1240 x 1240 pixels; pediatric retinal photograph (wide-field):
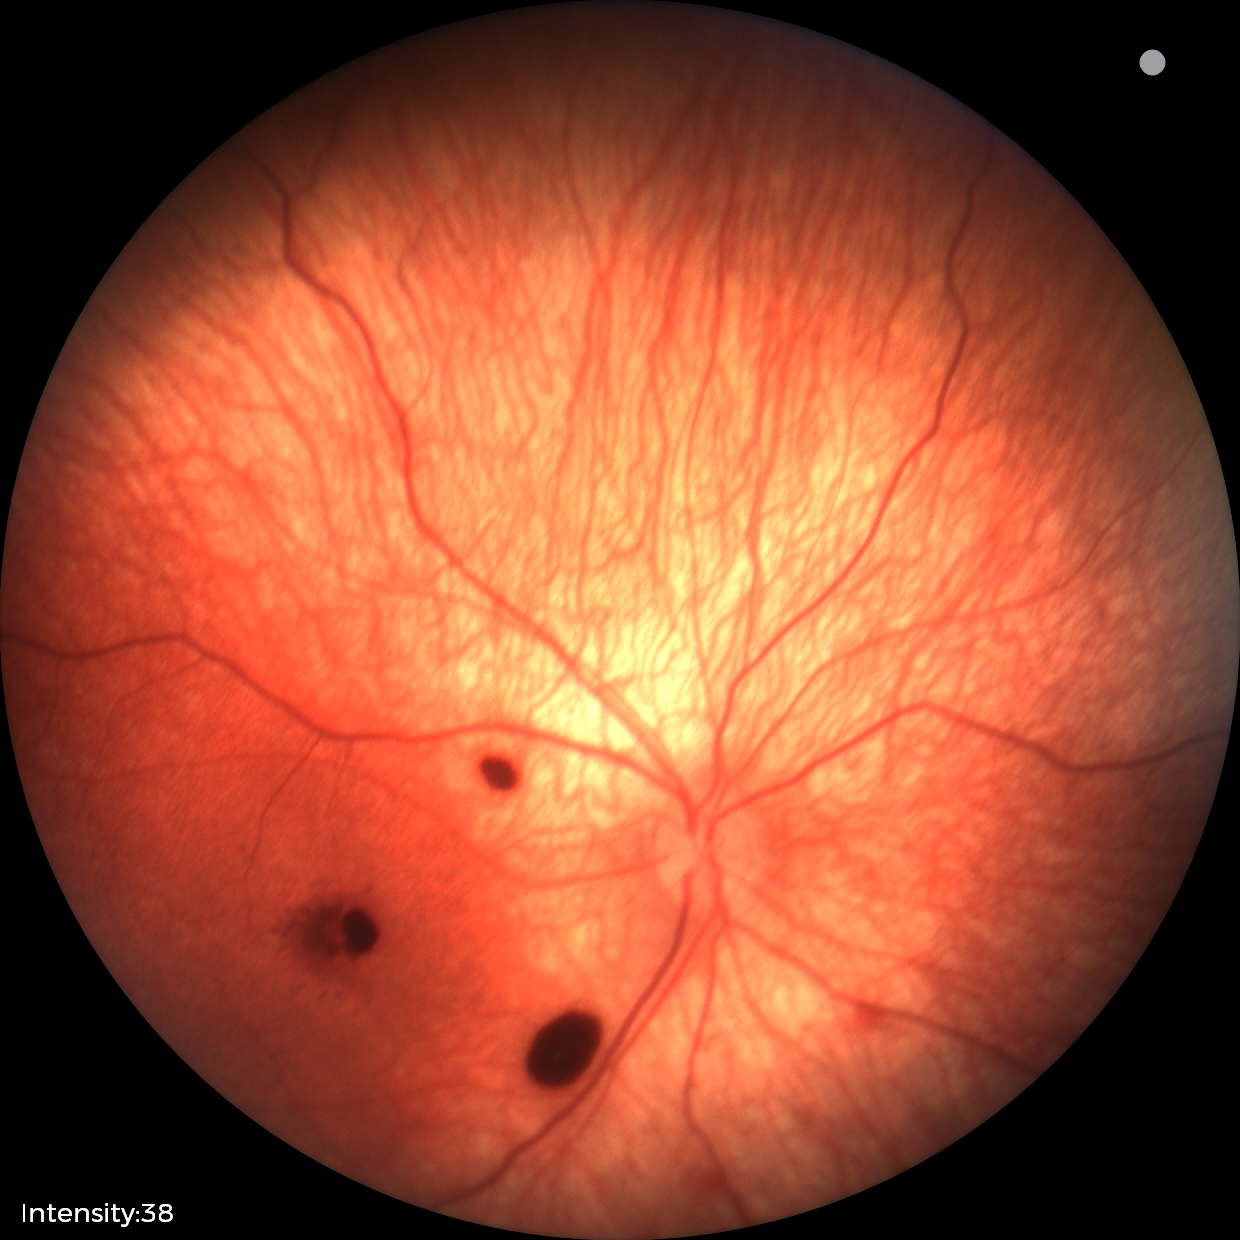
Examination diagnosed as retinal hemorrhages.